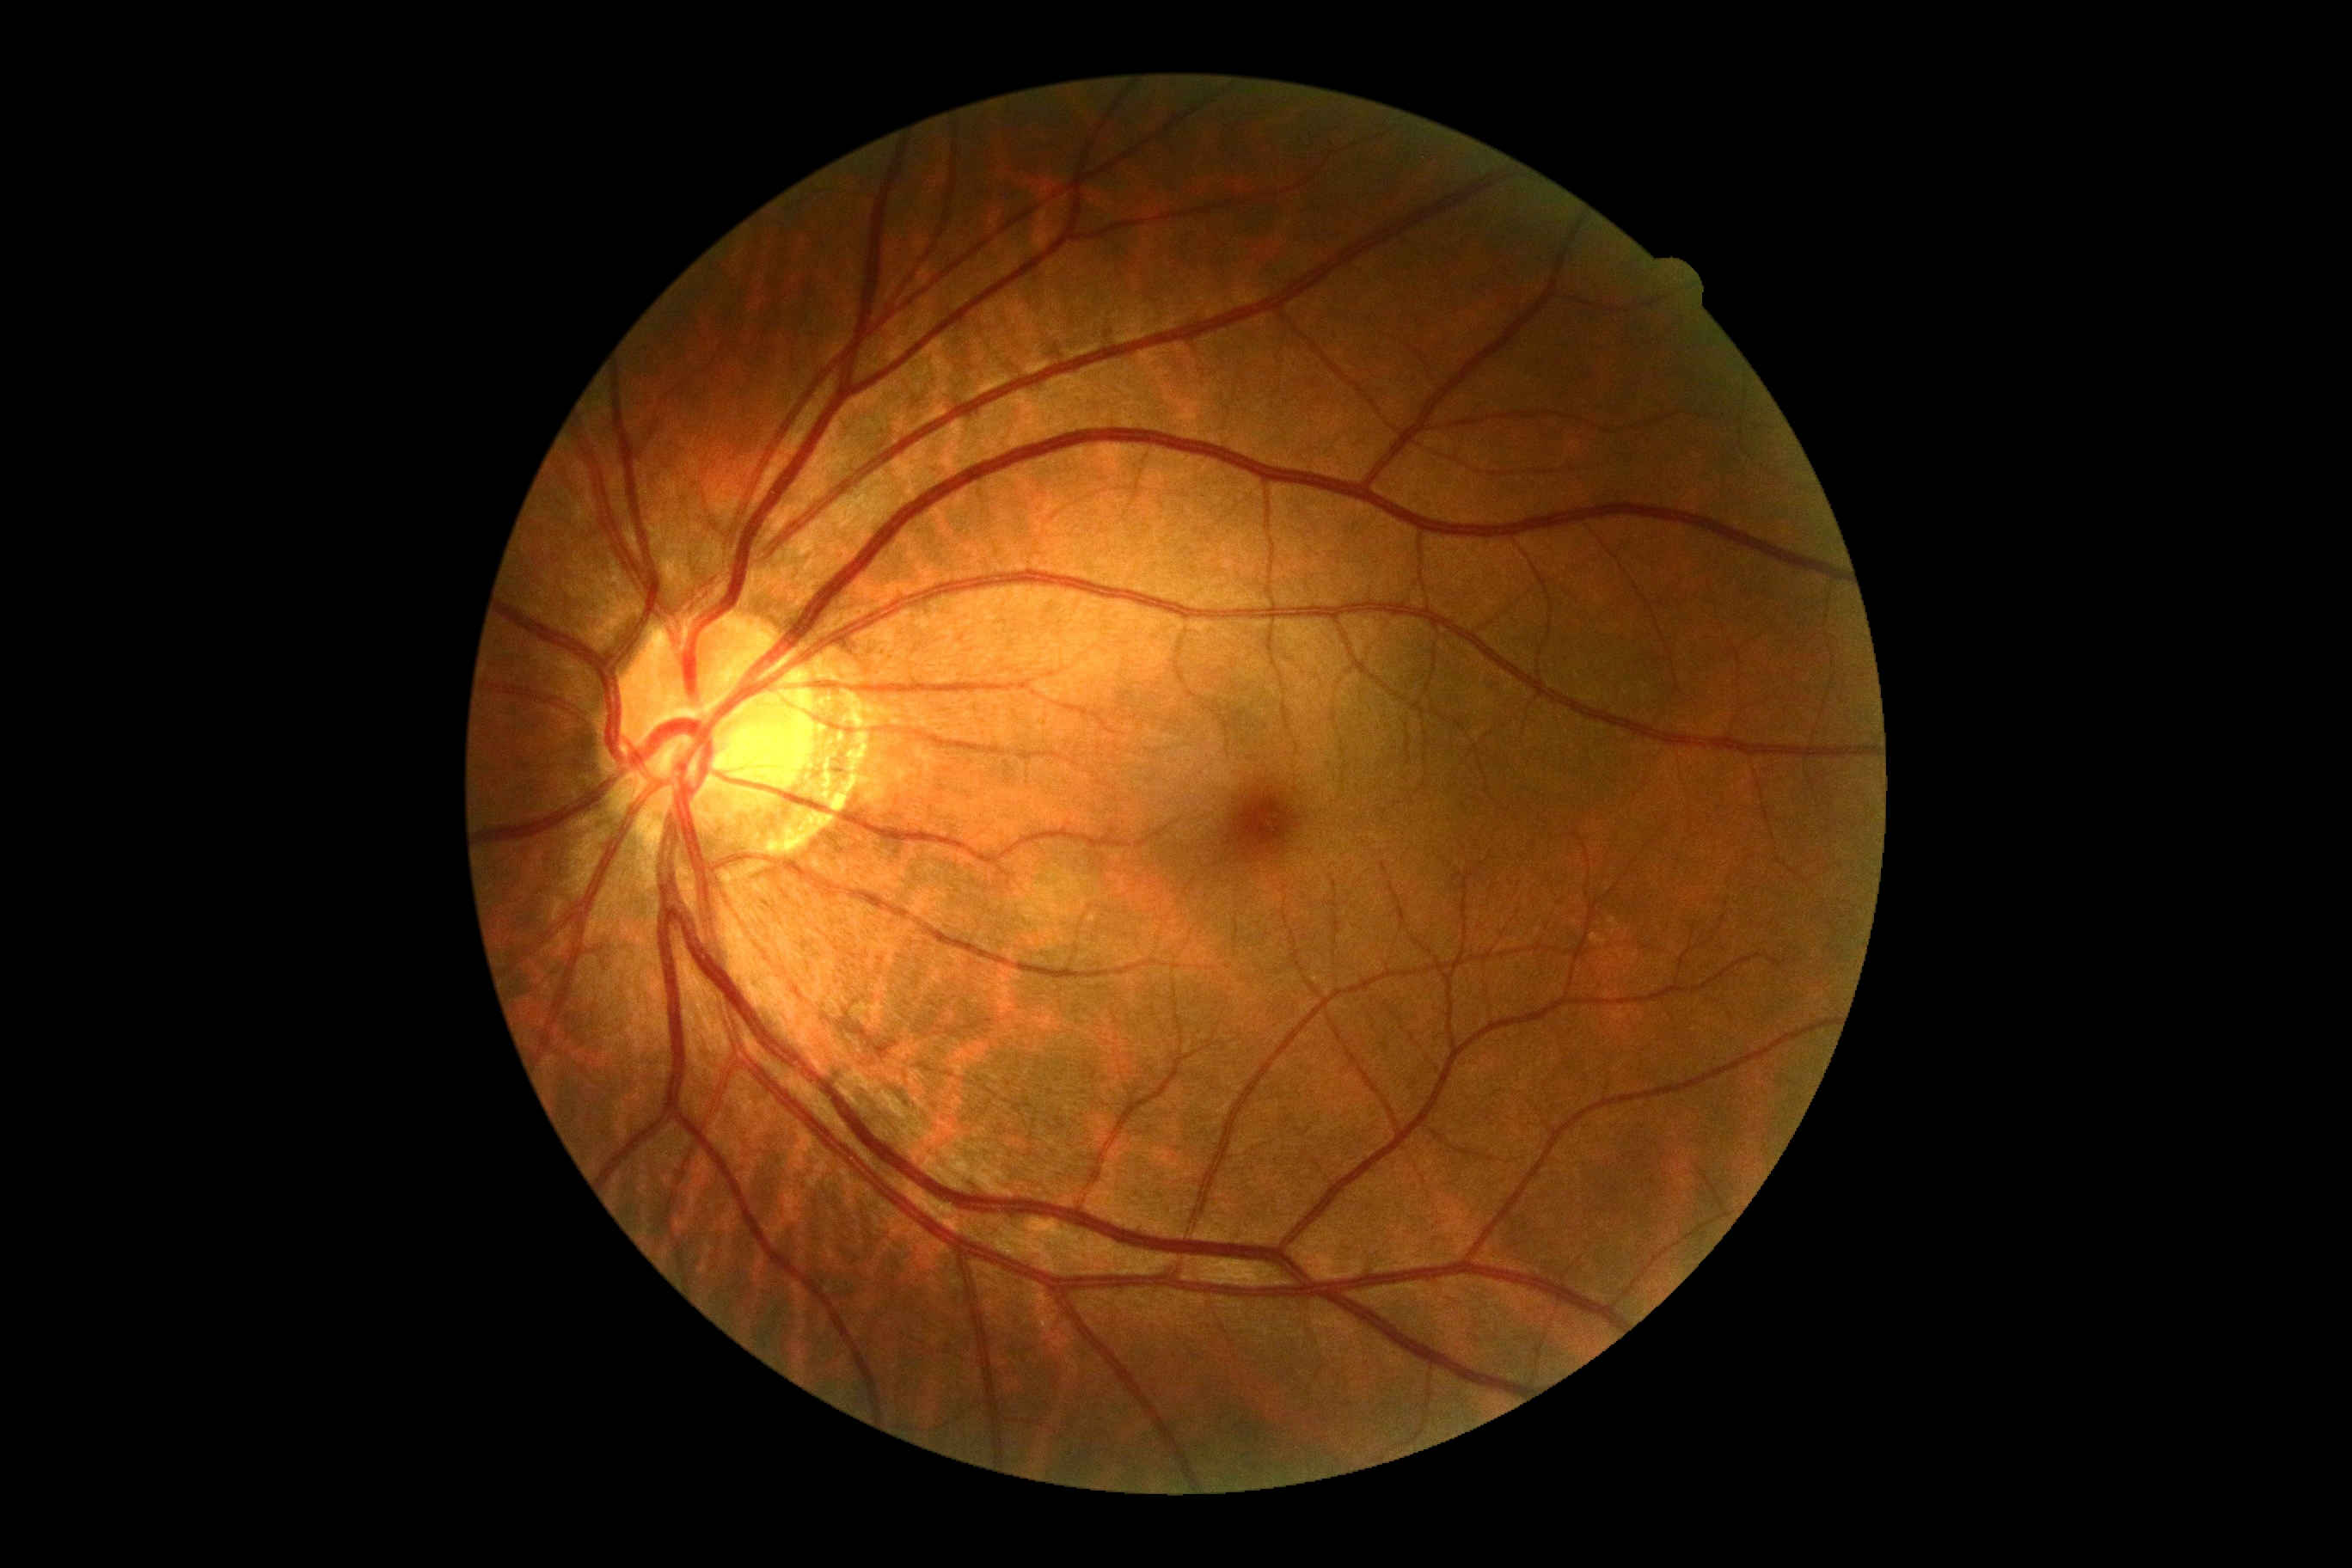
Diabetic retinopathy: 0/4.